Mydriatic (tropicamide and phenylephrine) · 50-degree field of view: 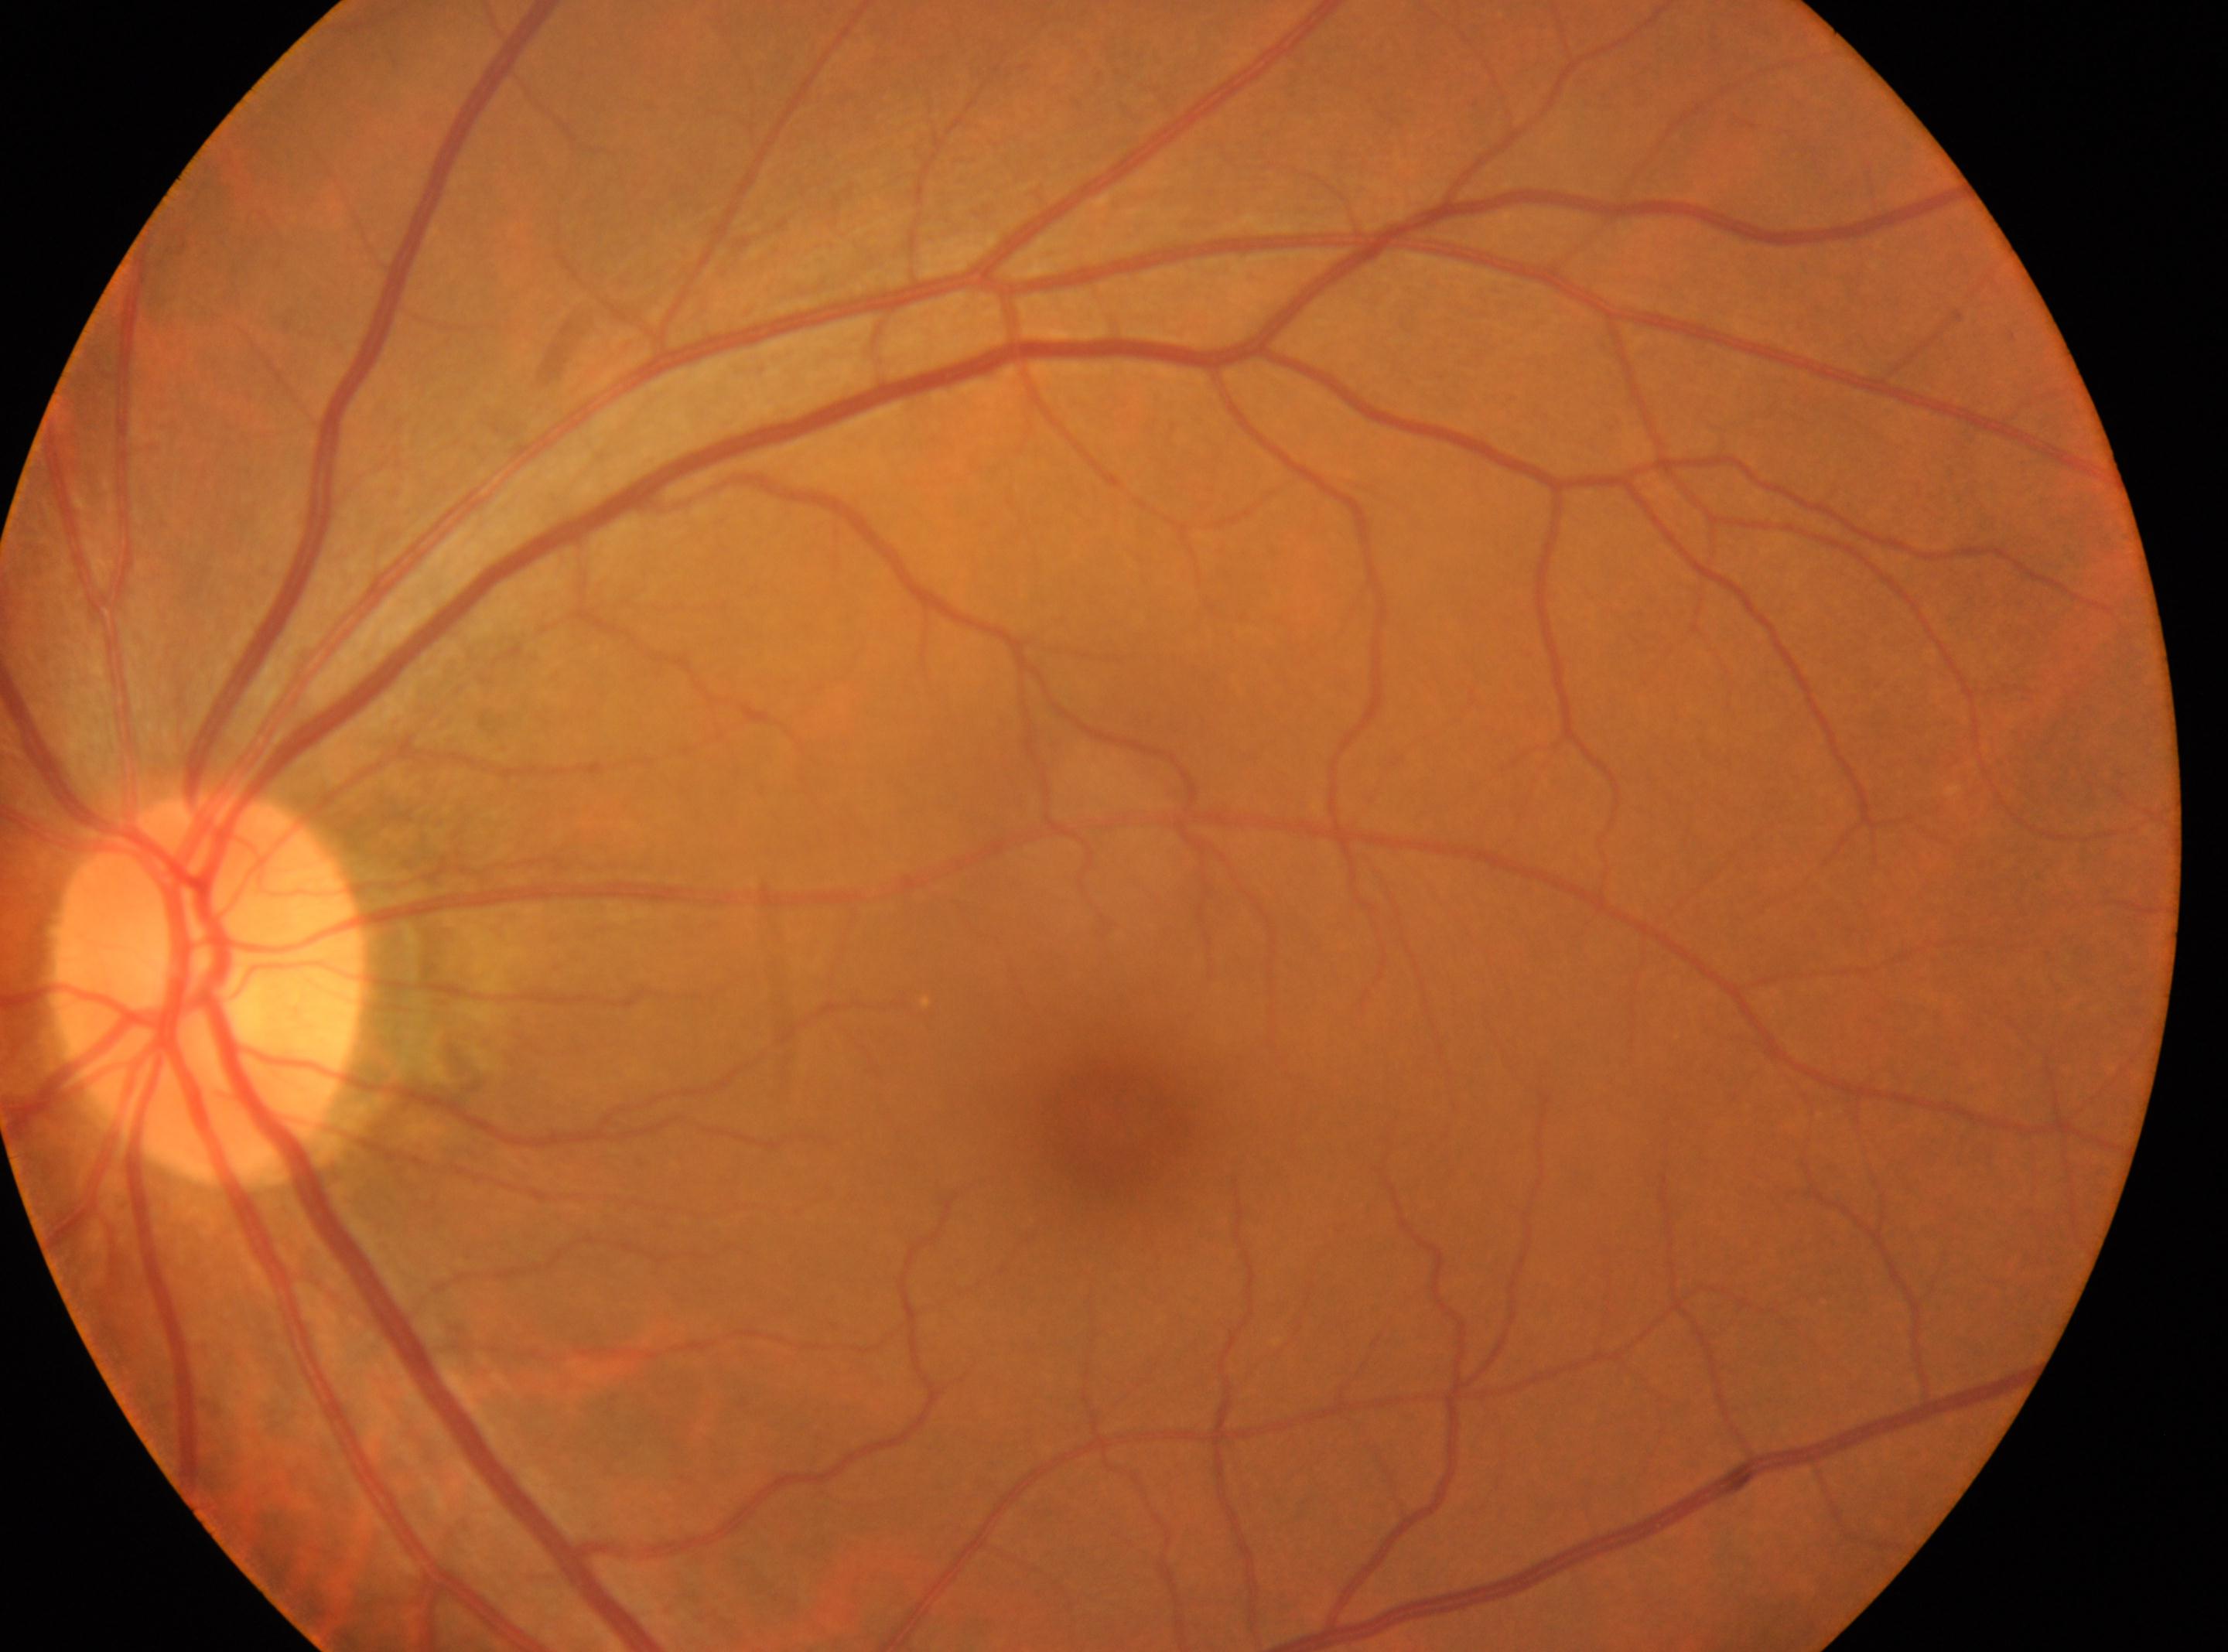
macula center@[1106, 1125]; optic disc@[206, 988]; No DR findings; OS; diabetic retinopathy (DR)@0/4.